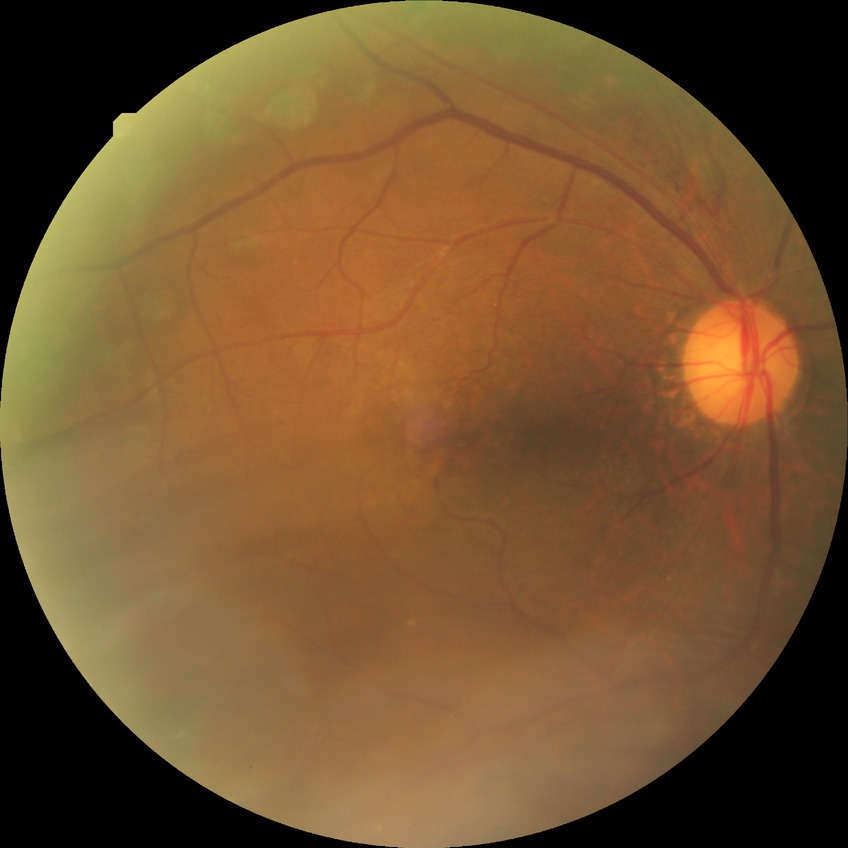

diabetic retinopathy (DR) = PDR (proliferative diabetic retinopathy).